Retinal fundus photograph · FOV: 45 degrees · image size 2212x1659:
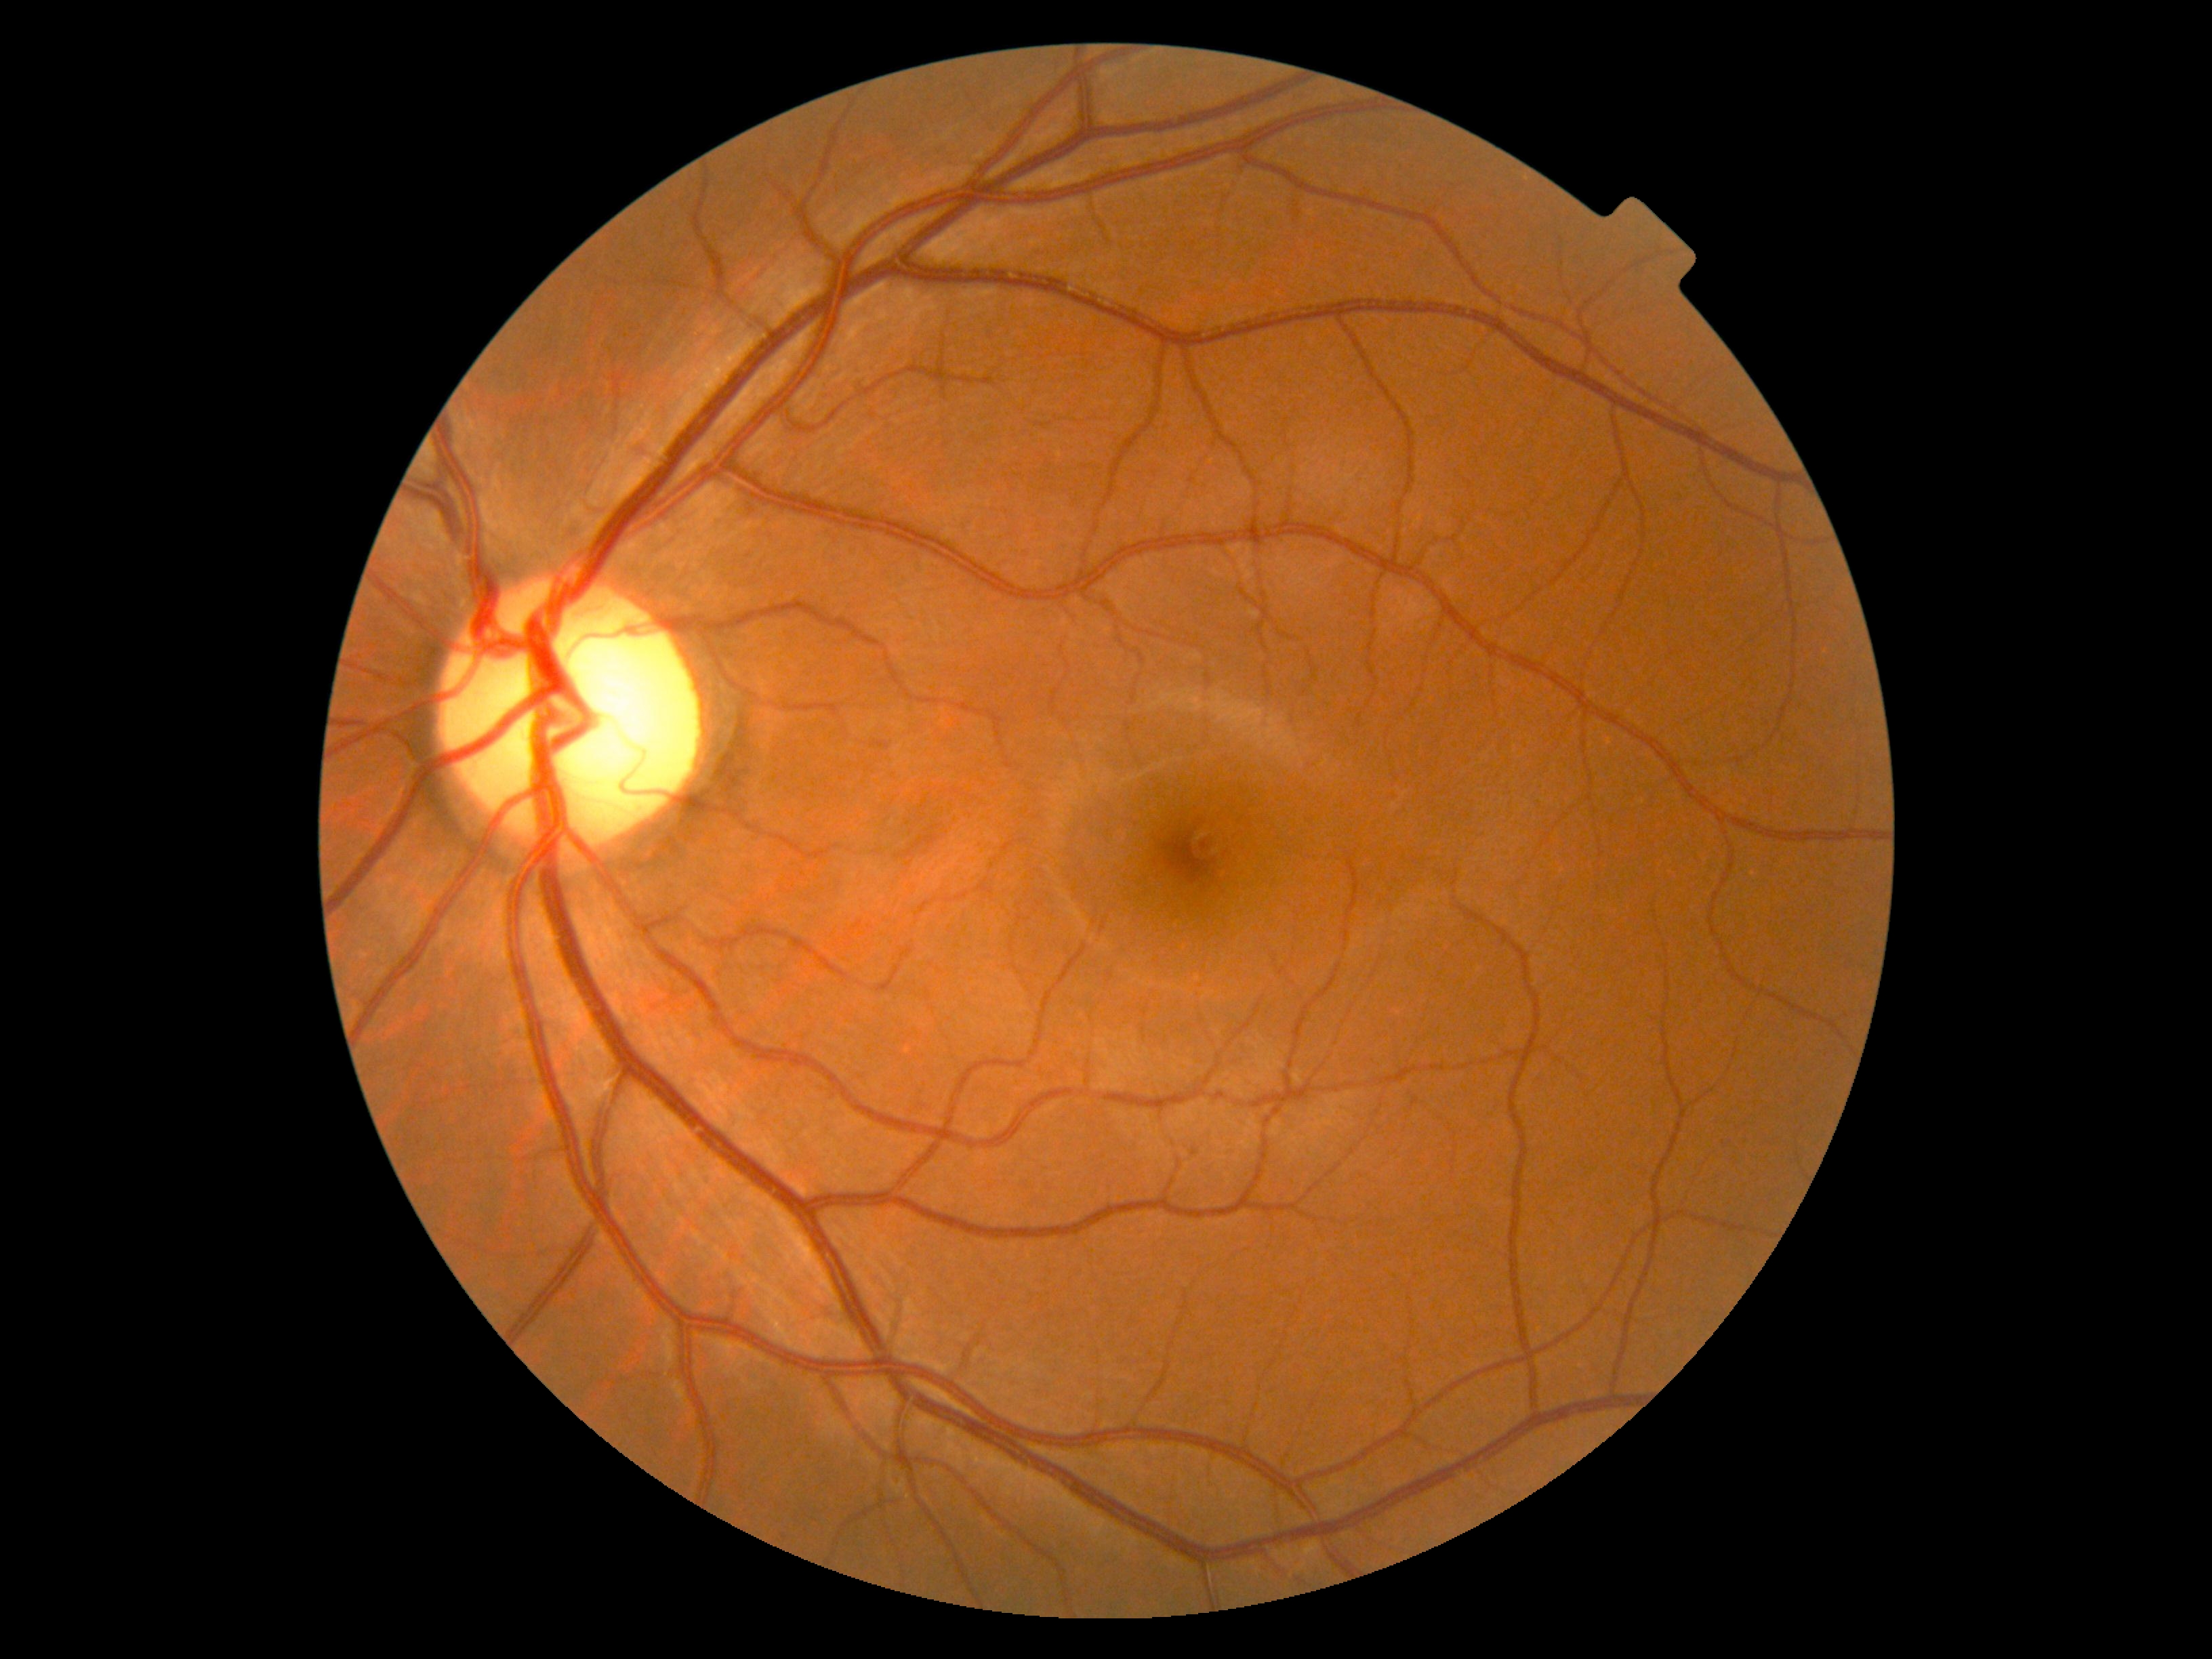
Findings:
- DR stage: 0